45-degree field of view — 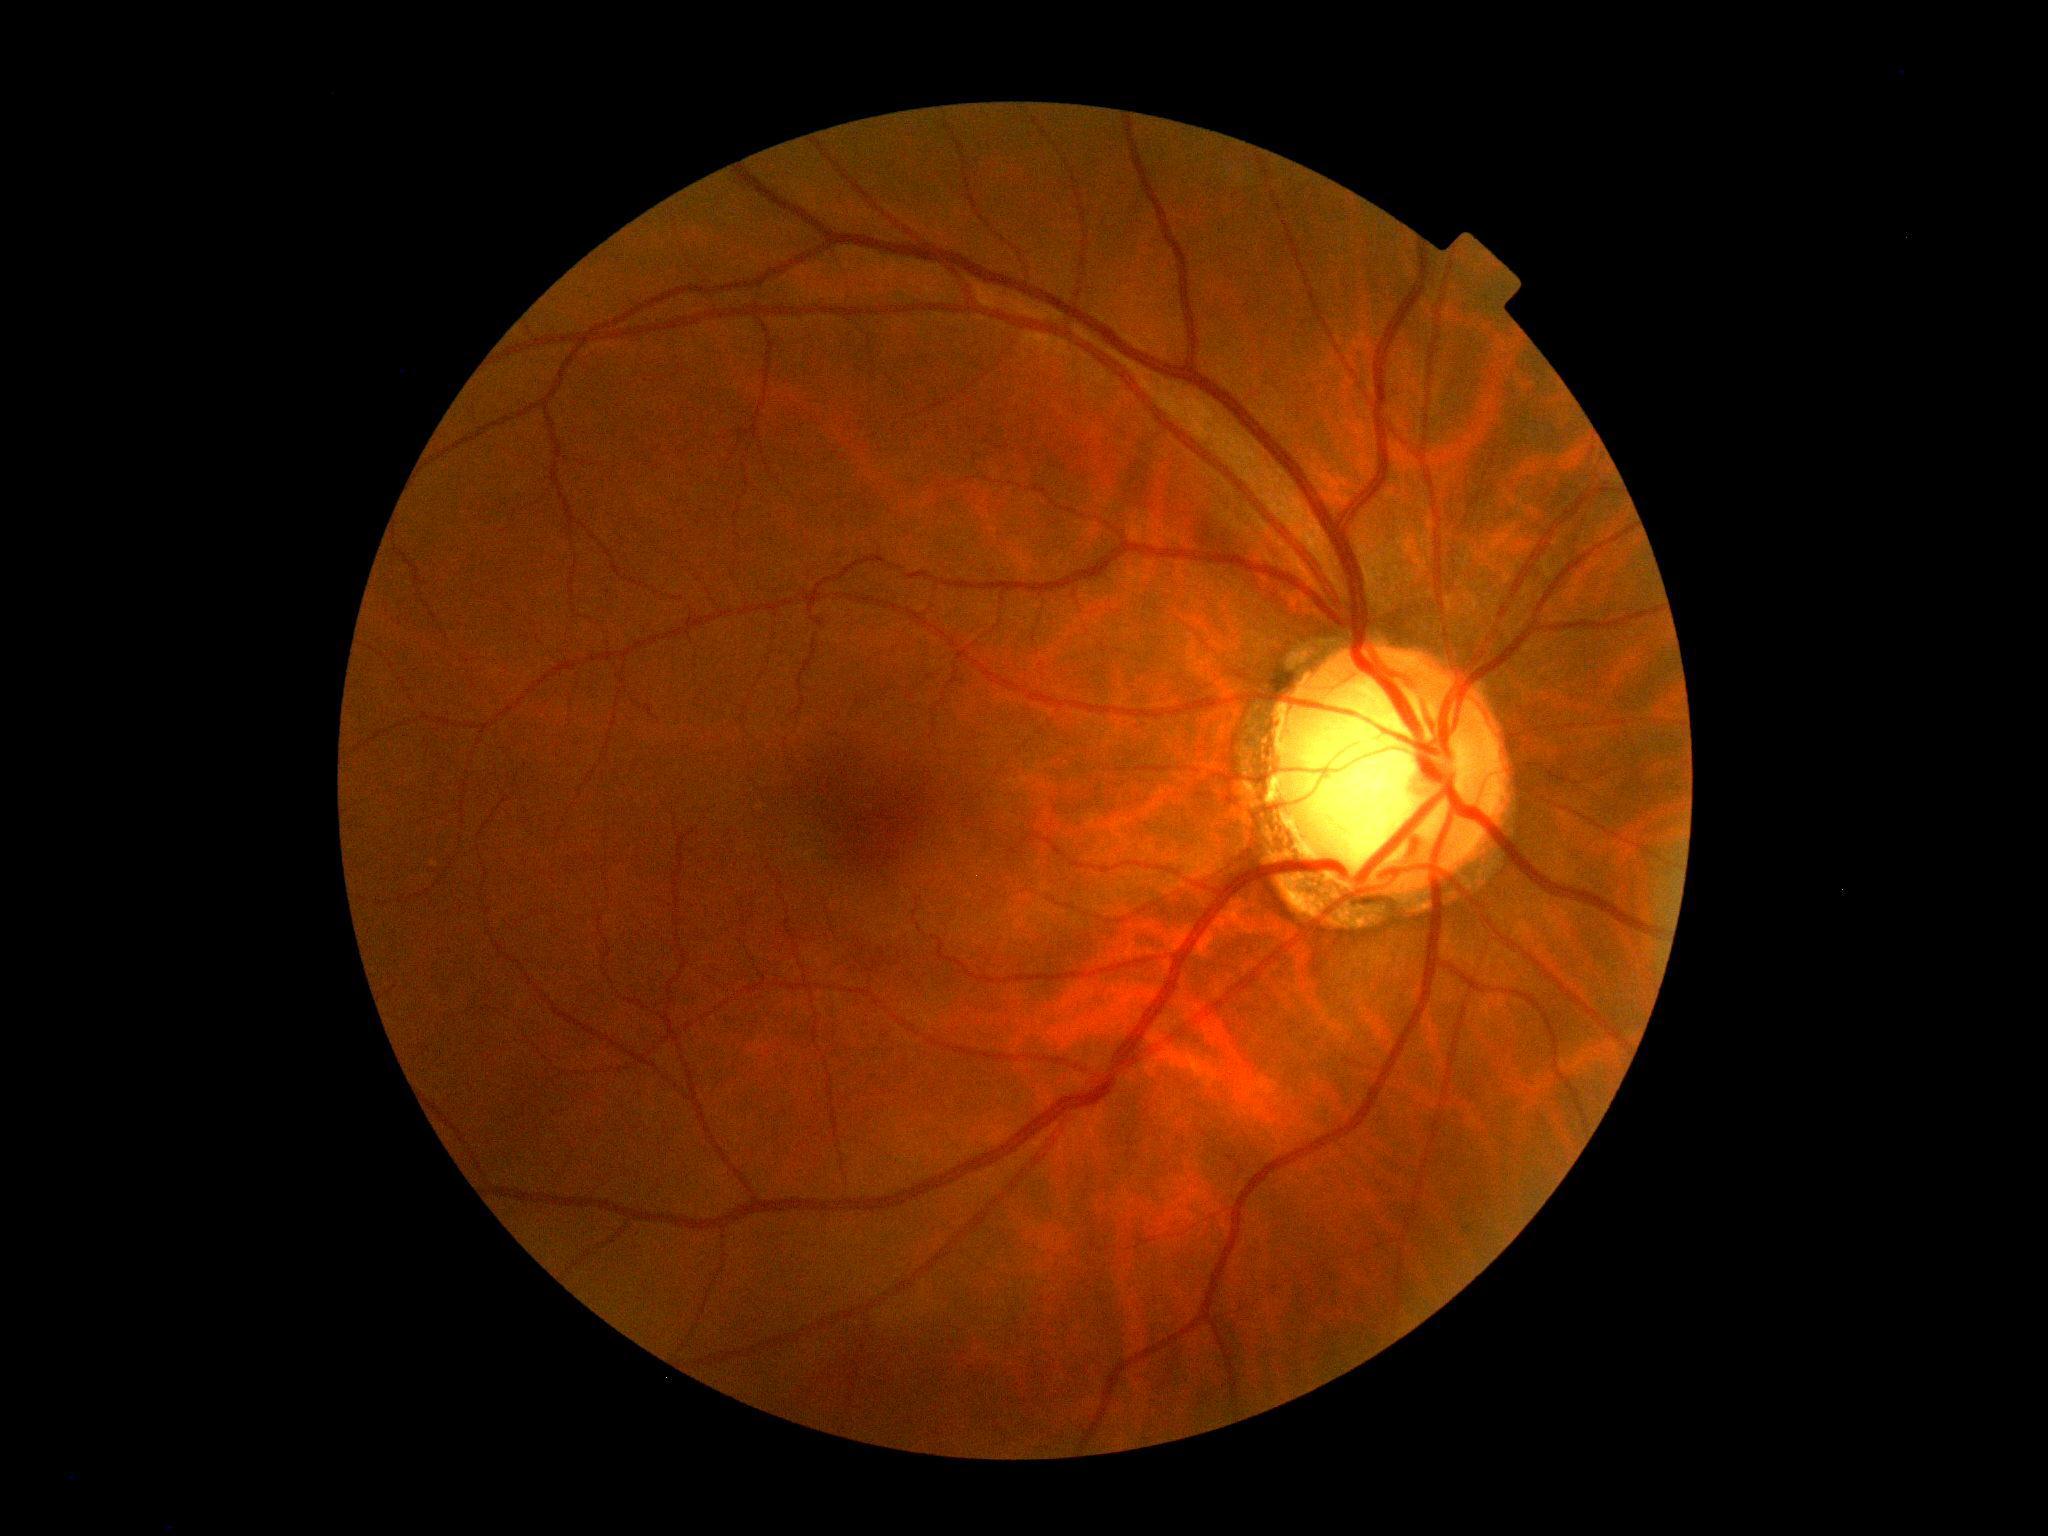

Retinopathy: 0/4.